45° field of view:
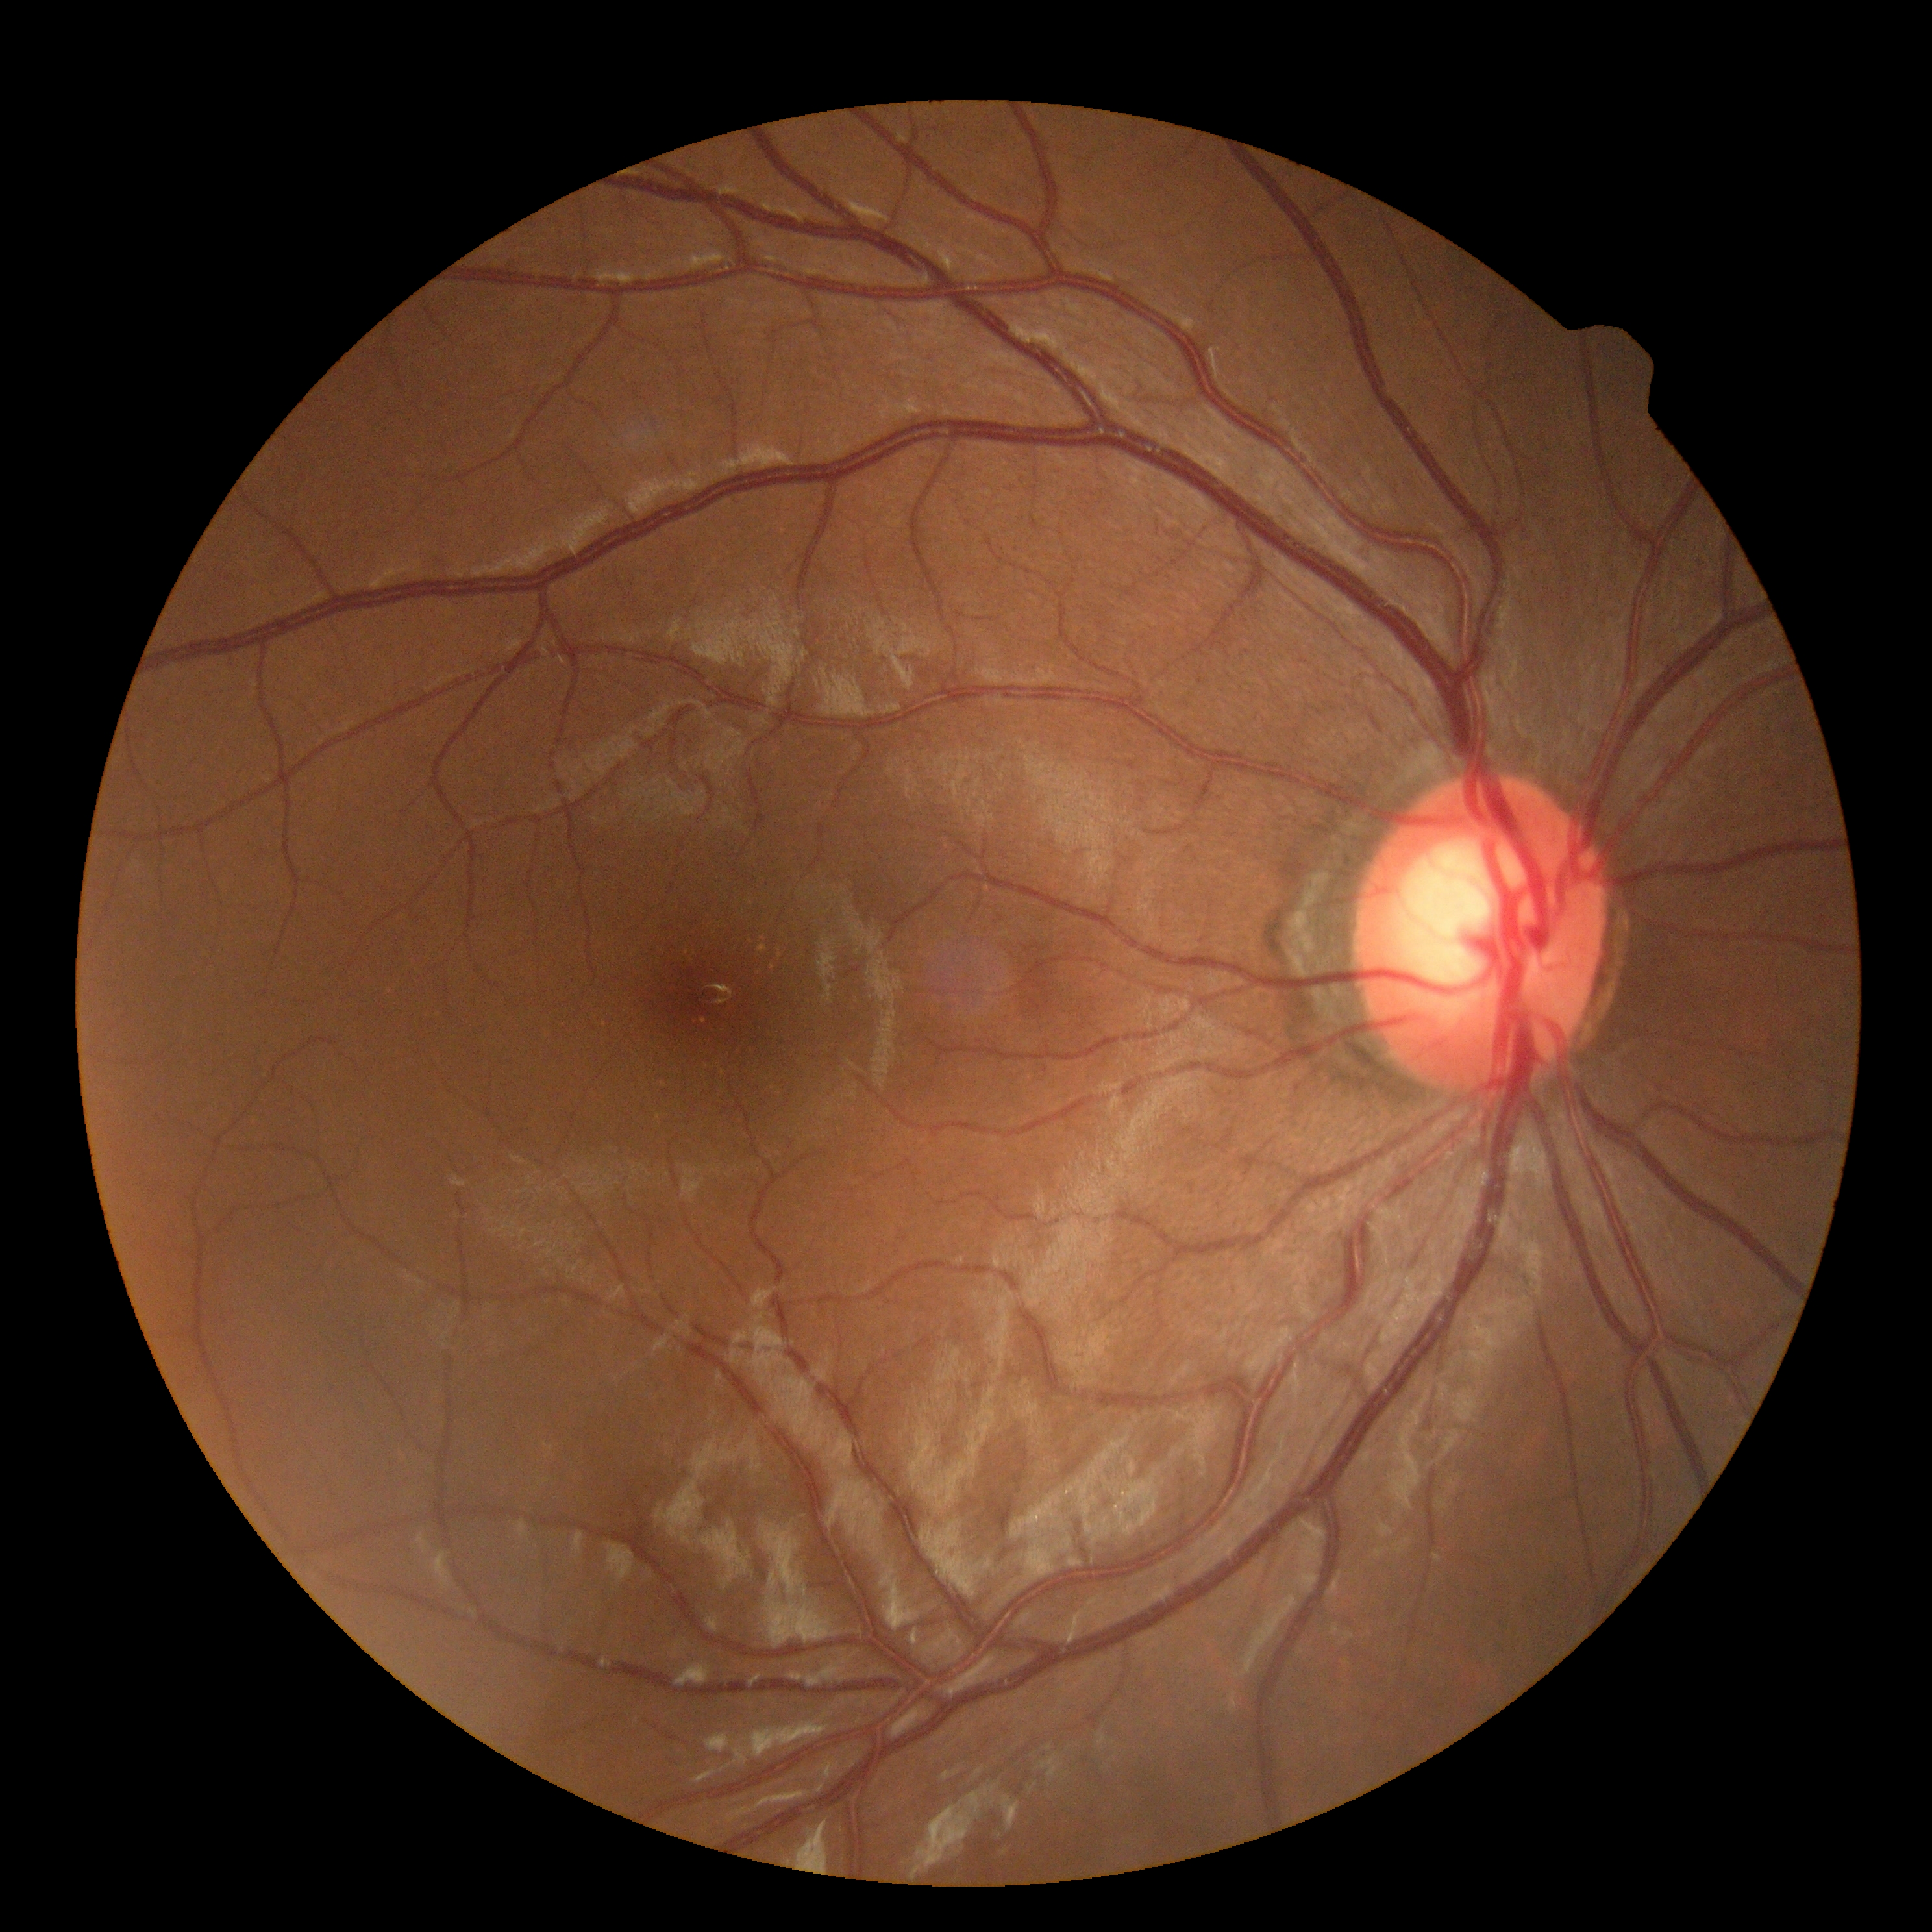 DR stage is grade 0 (no apparent retinopathy).